Wide-field fundus photograph from neonatal ROP screening:
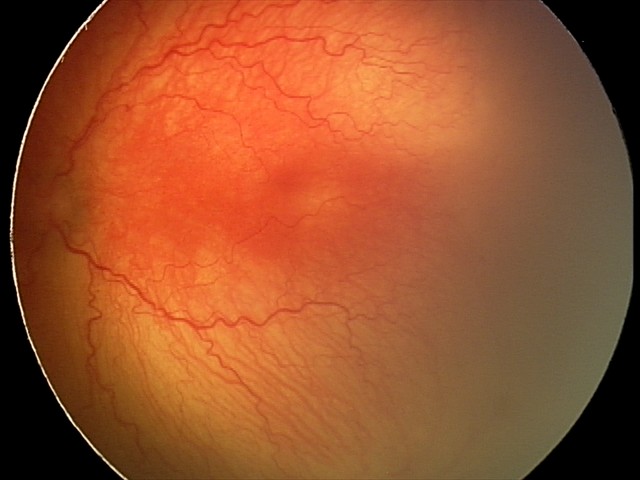

Screening examination consistent with A-ROP (aggressive ROP). Plus disease present.